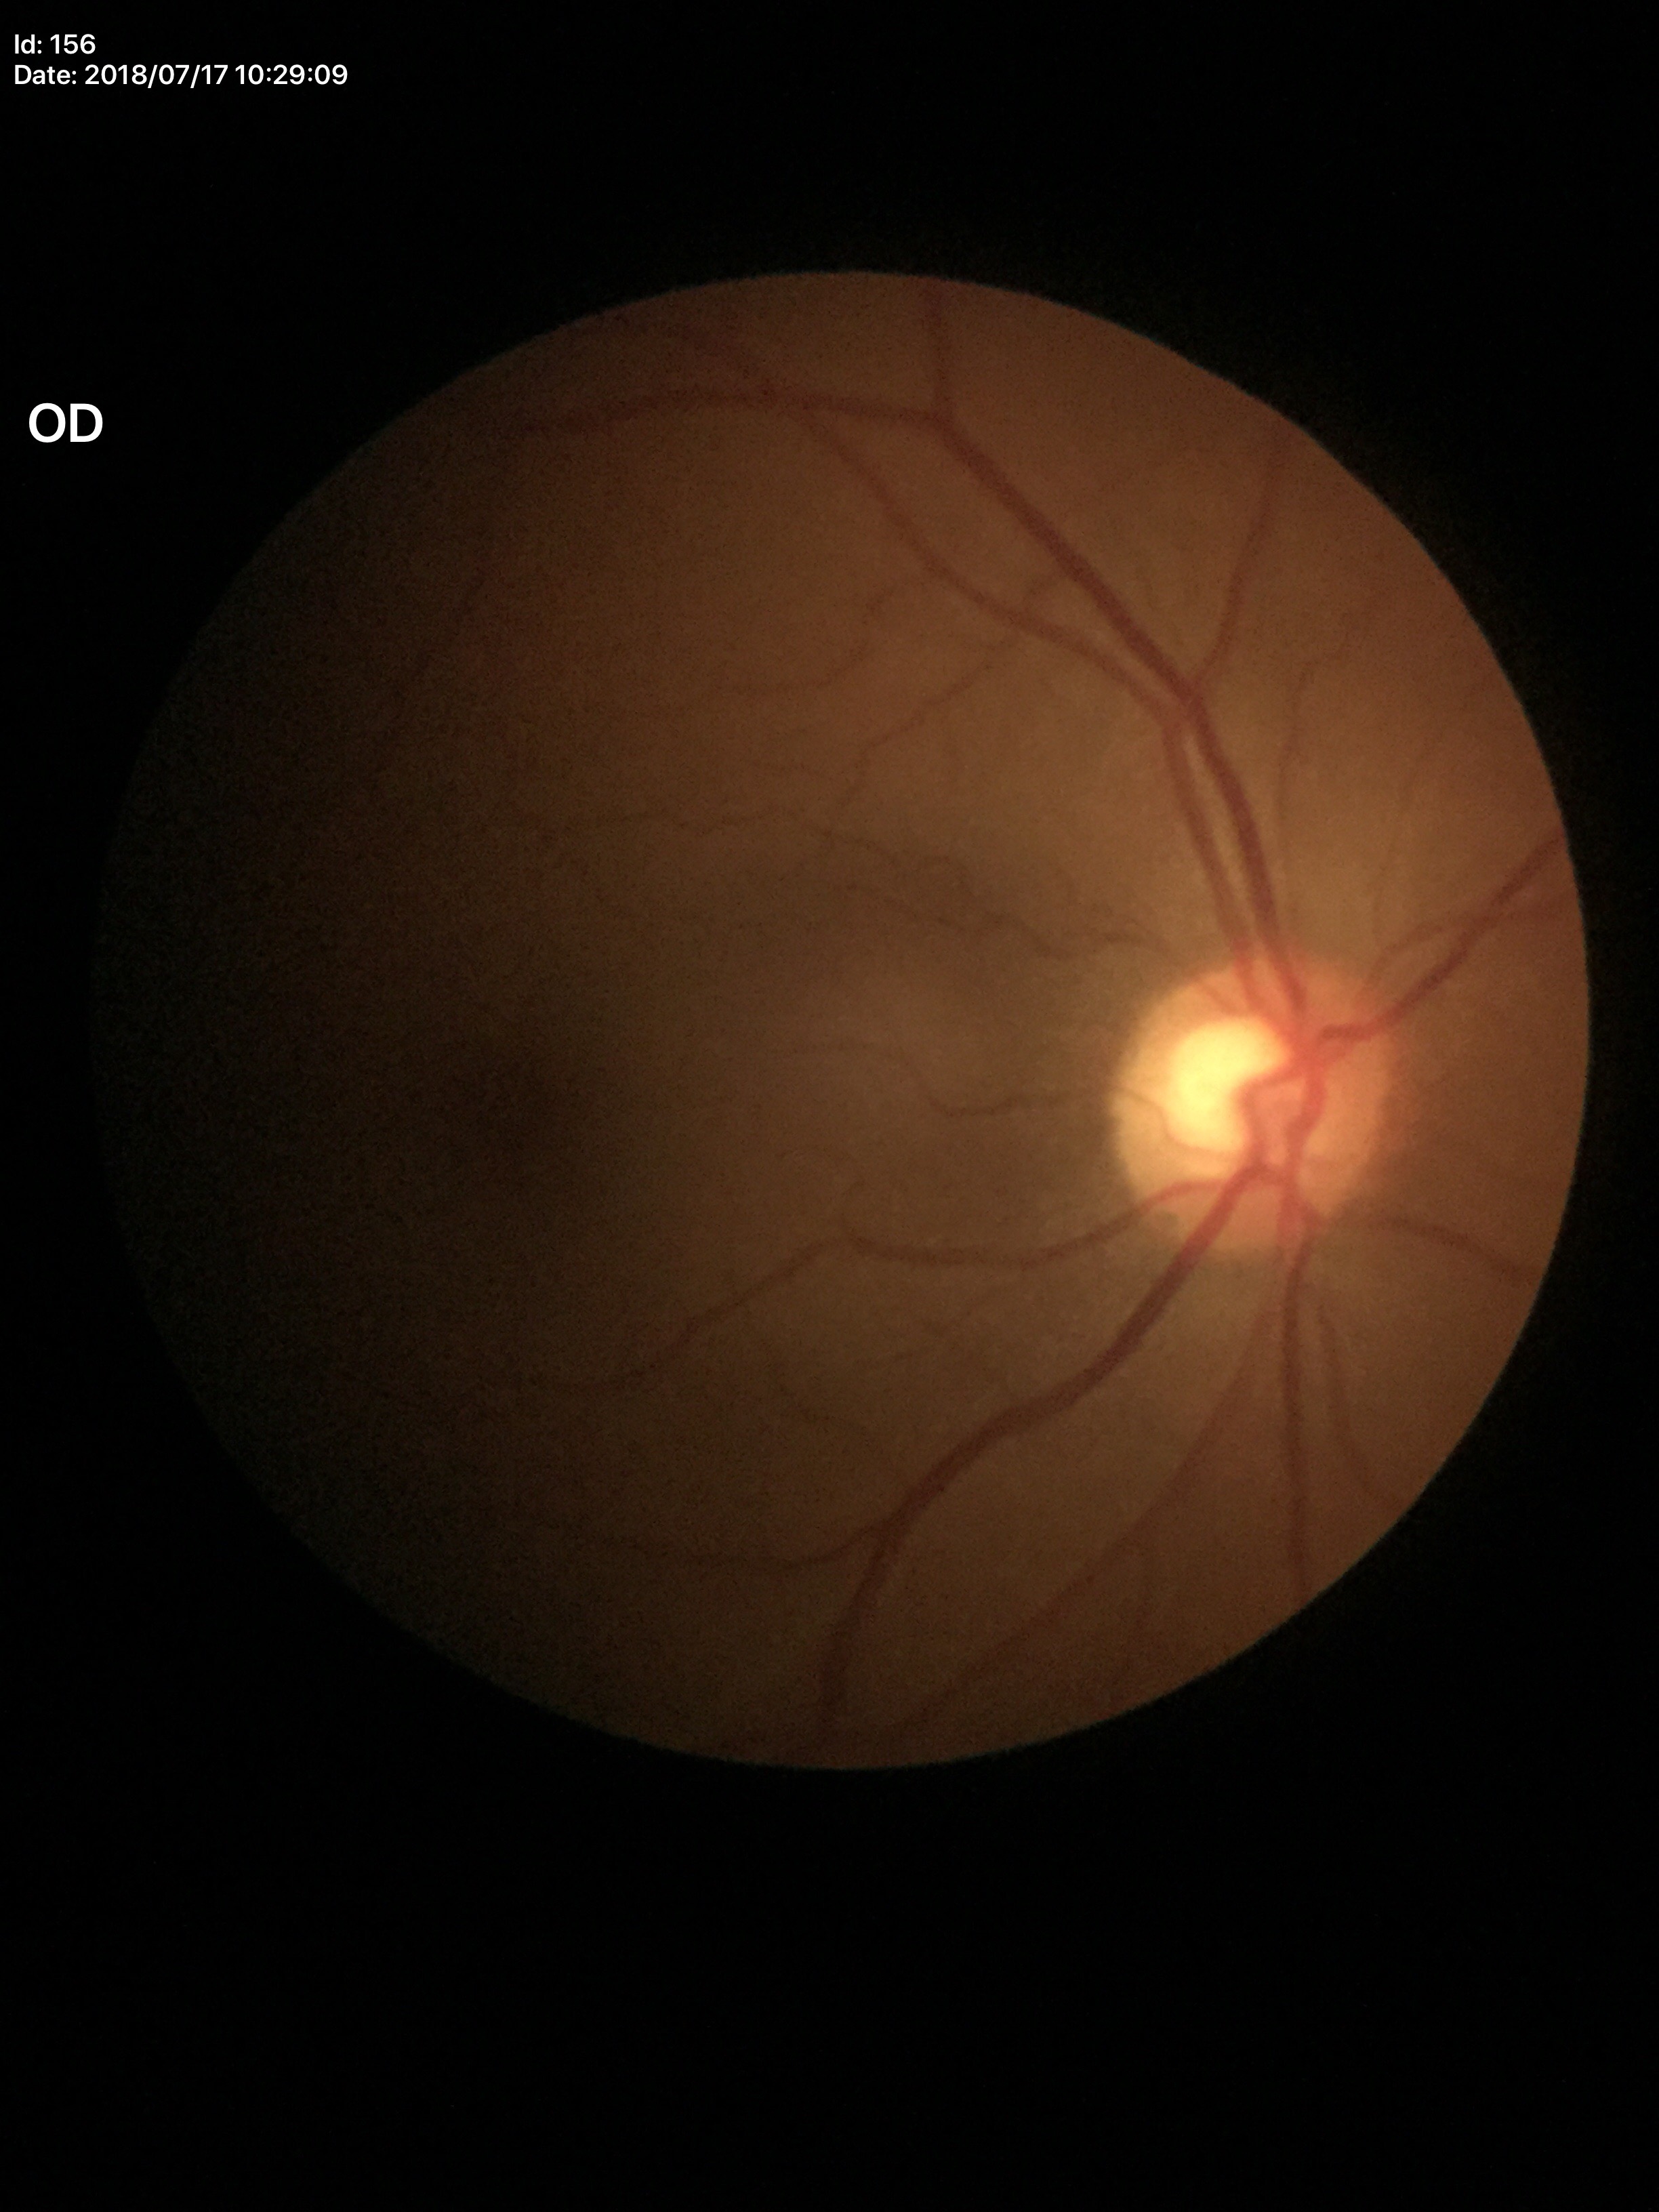
Glaucoma screening impression: no suspicious findings (2/5 graders called glaucoma suspect).
VCDR of 0.60.